FOV: 45 degrees. Graded on the modified Davis scale. Nonmydriatic — 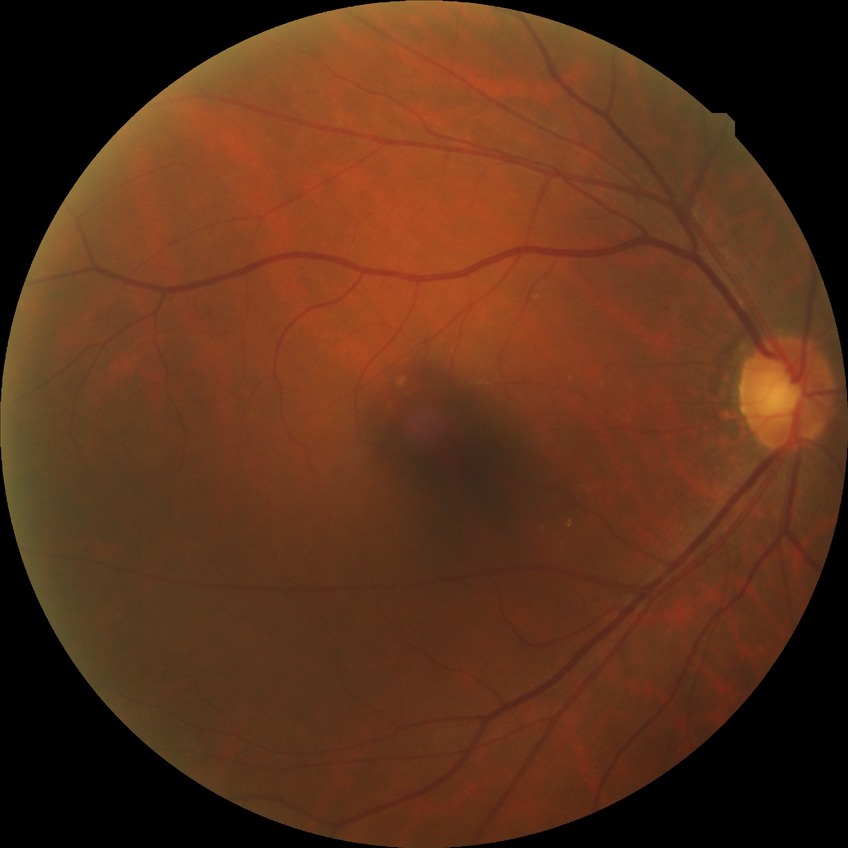 Davis grade@NDR, DR impression@negative for DR.